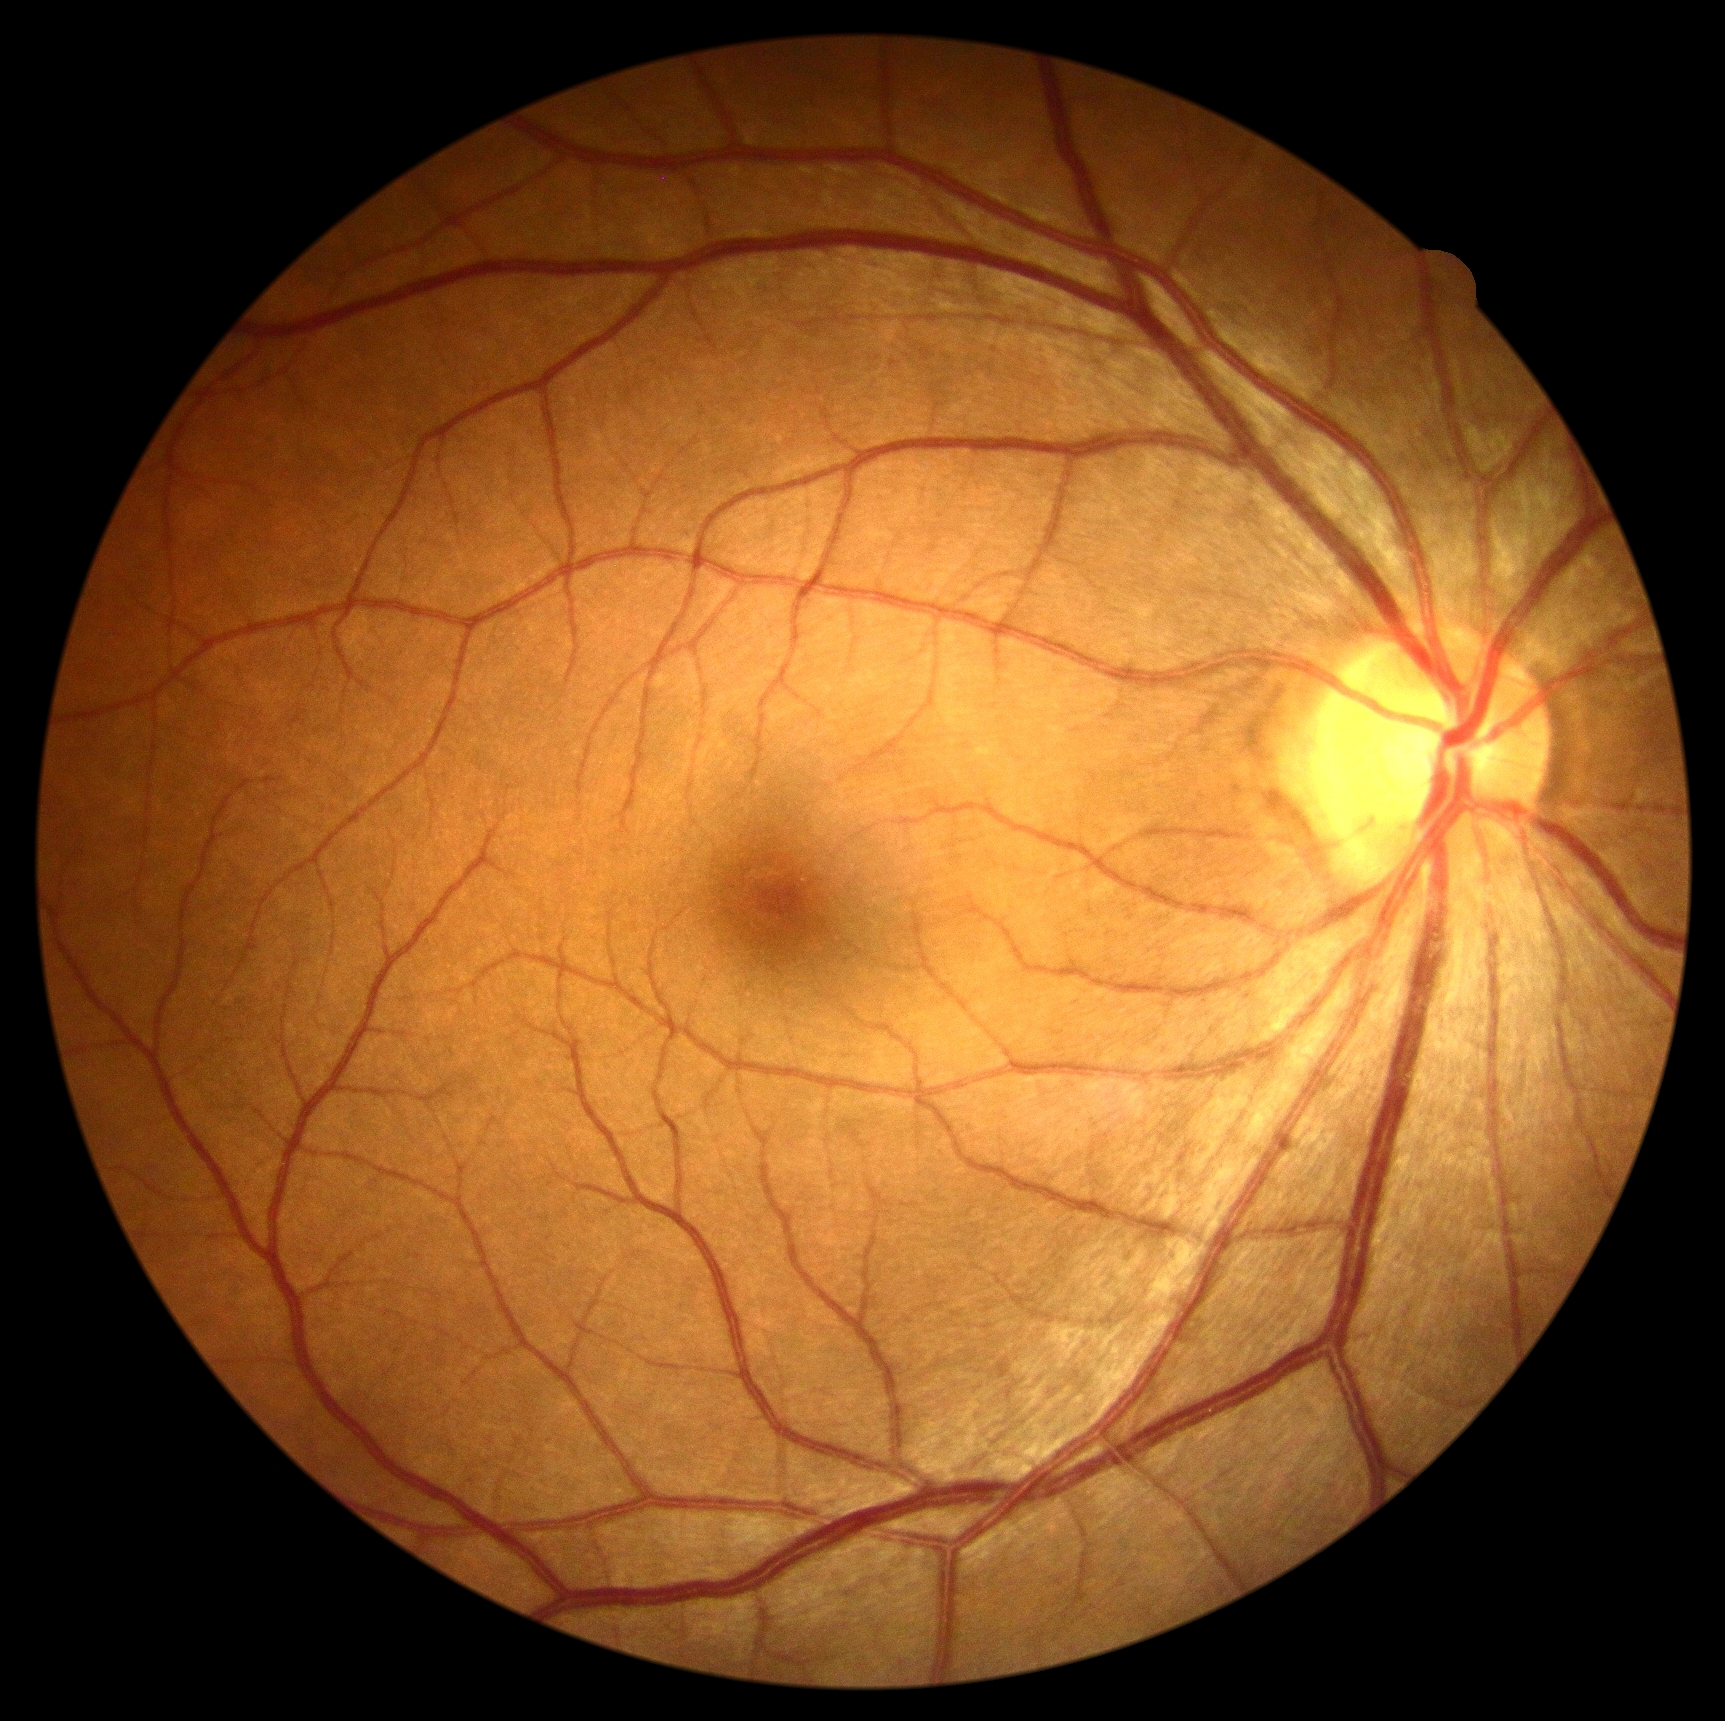

DR grade is no apparent retinopathy (0).